Camera: NIDEK AFC-230. Modified Davis grading. FOV: 45 degrees. Nonmydriatic:
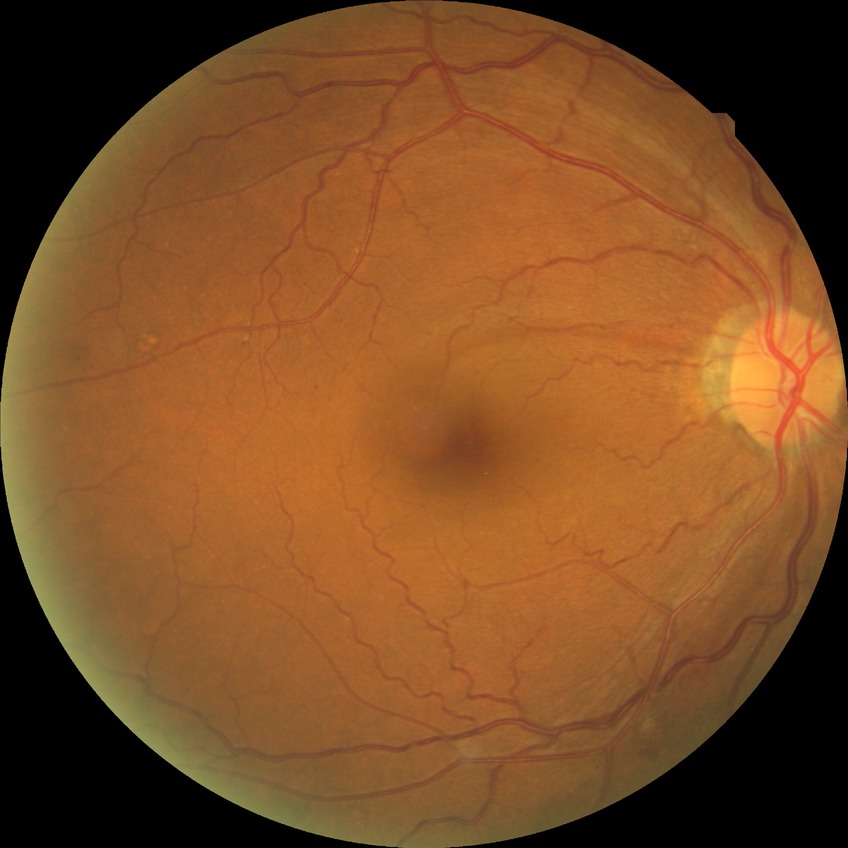 Diabetic retinopathy grade is no diabetic retinopathy.